2184x1682
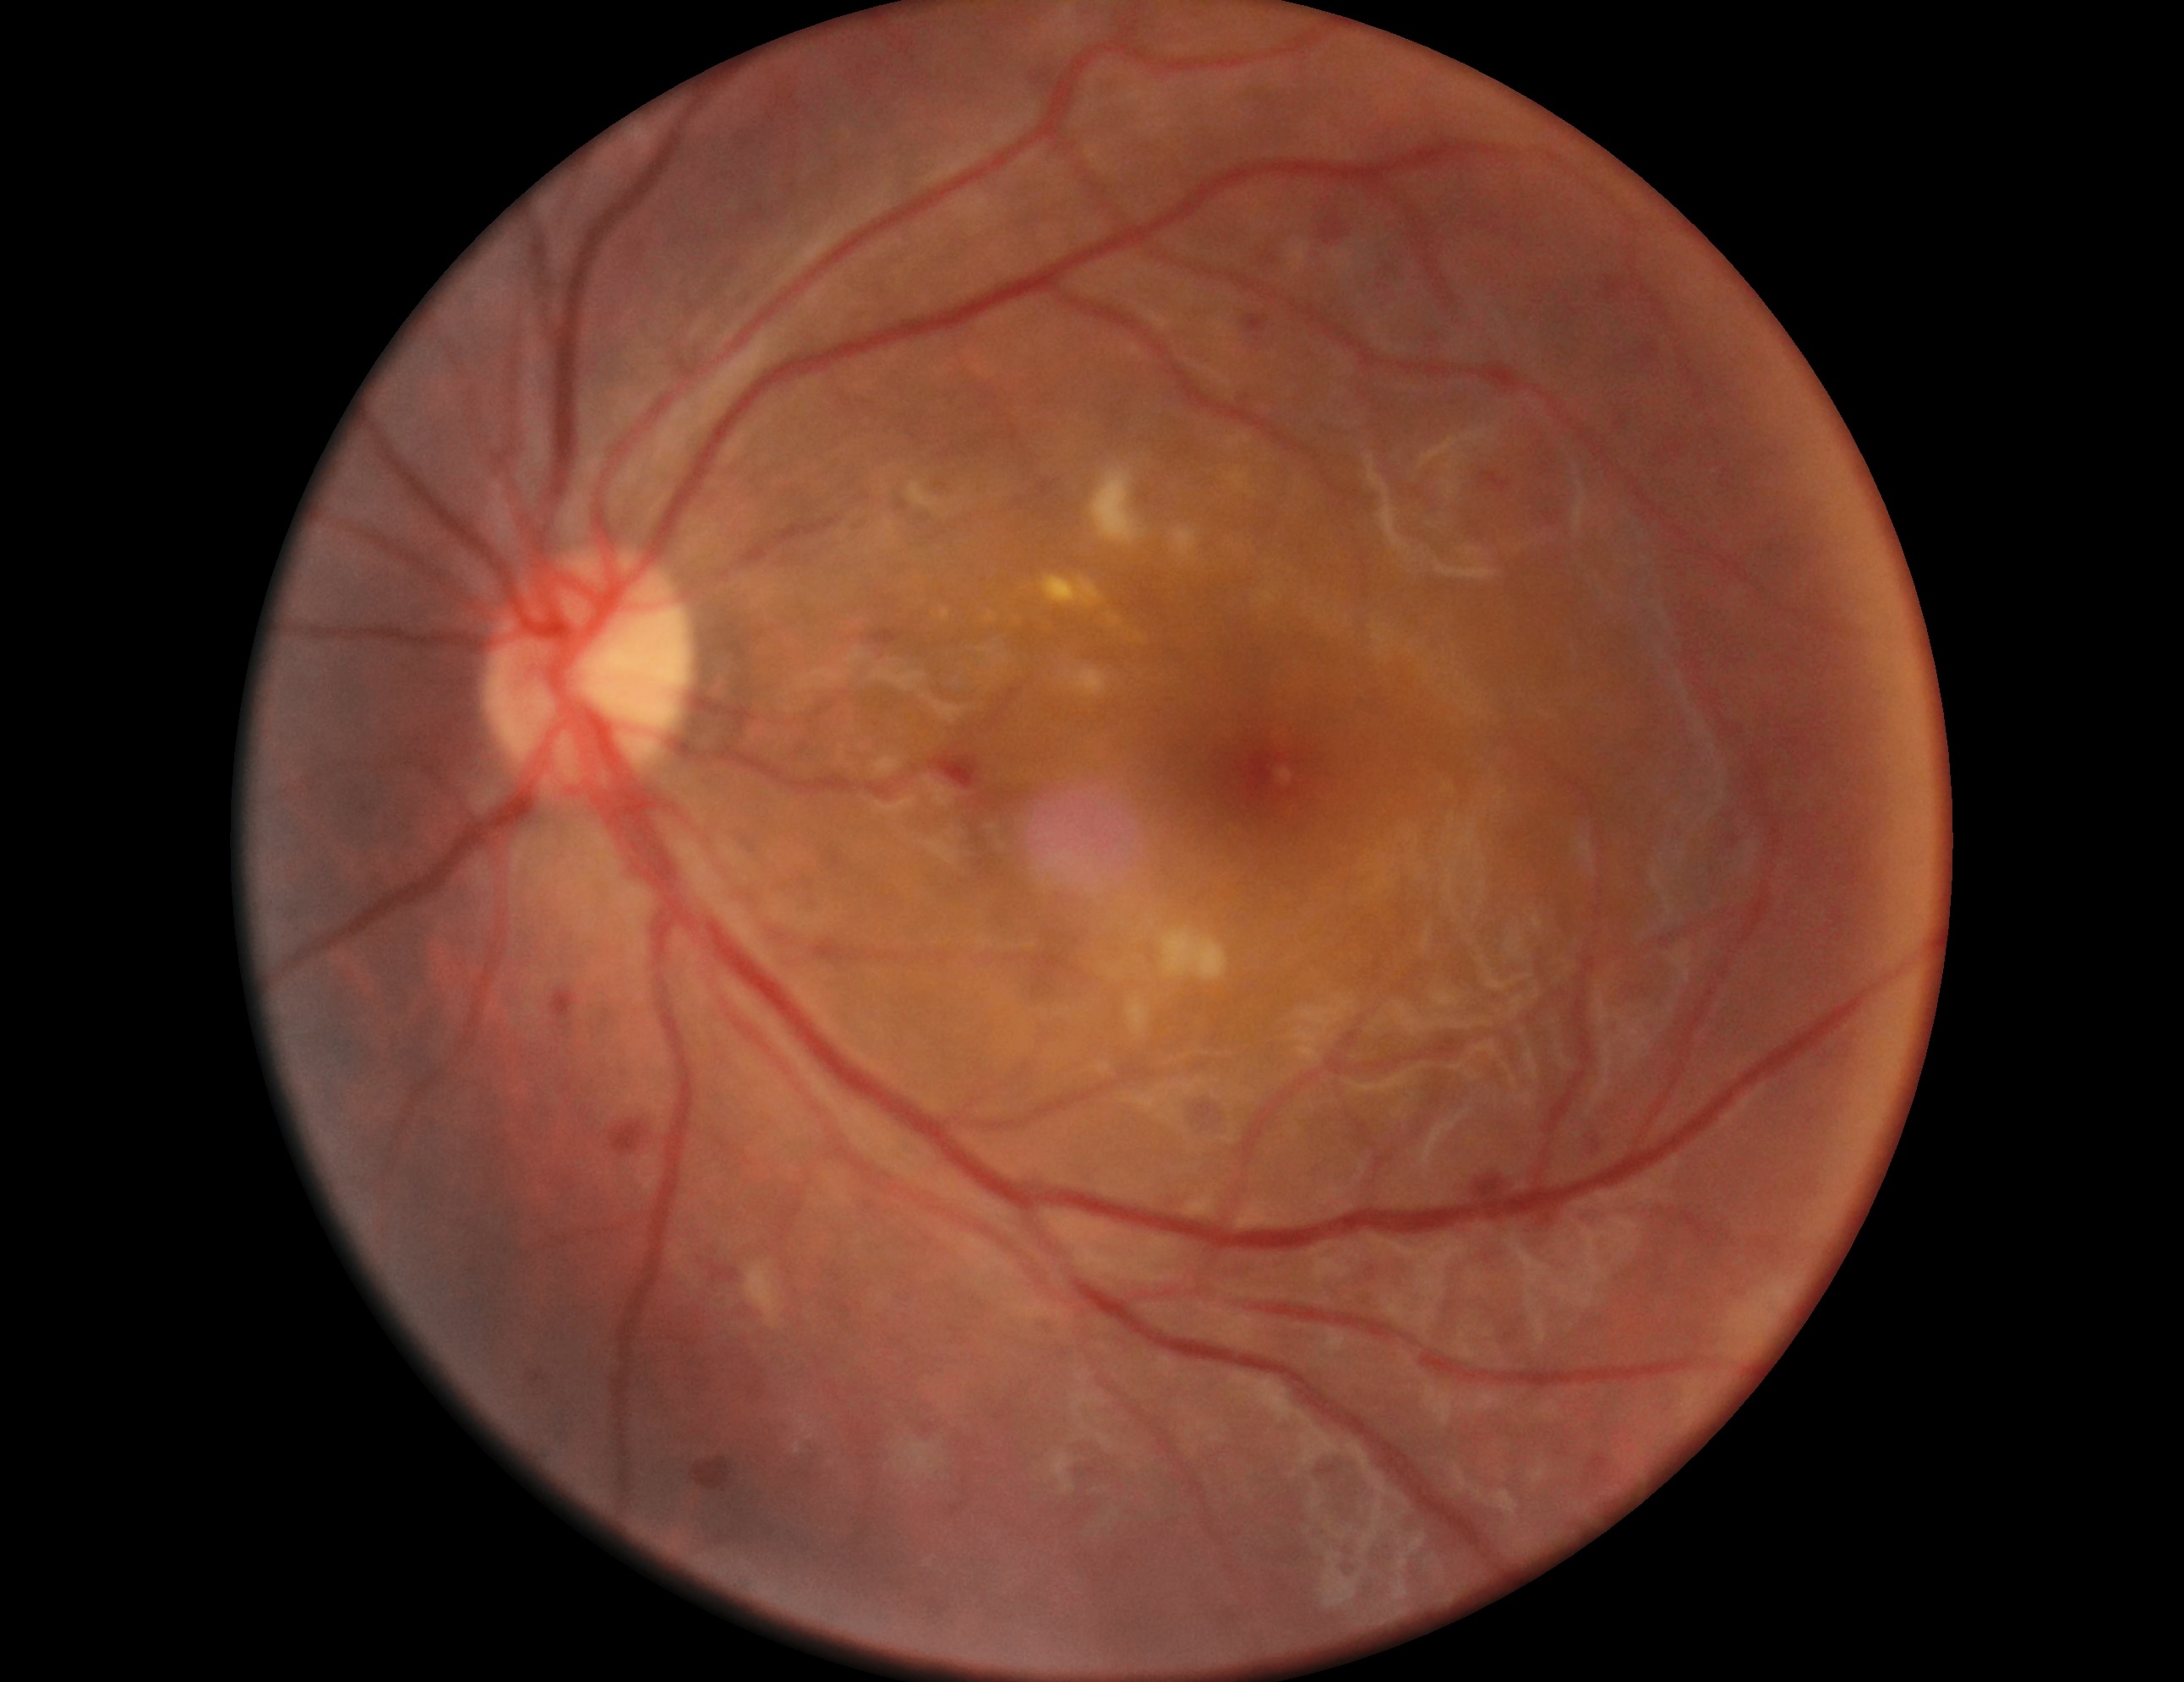
Diabetic retinopathy (DR) is grade 2 (moderate NPDR).